Acquired with a NIDEK AFC-230: 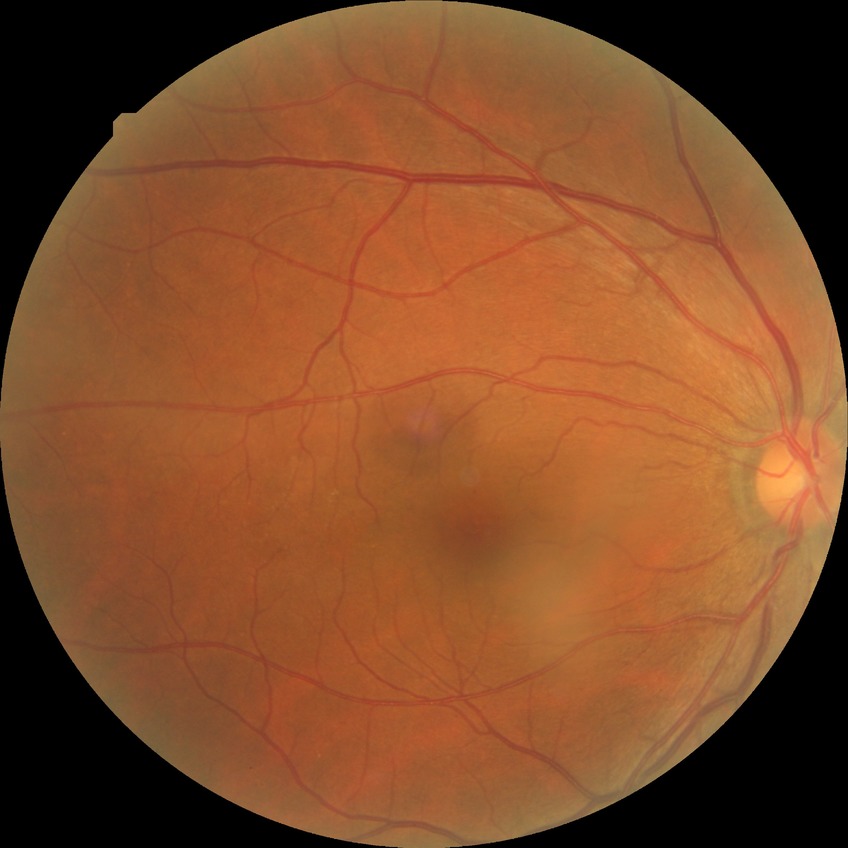

Diabetic retinopathy stage is no diabetic retinopathy.